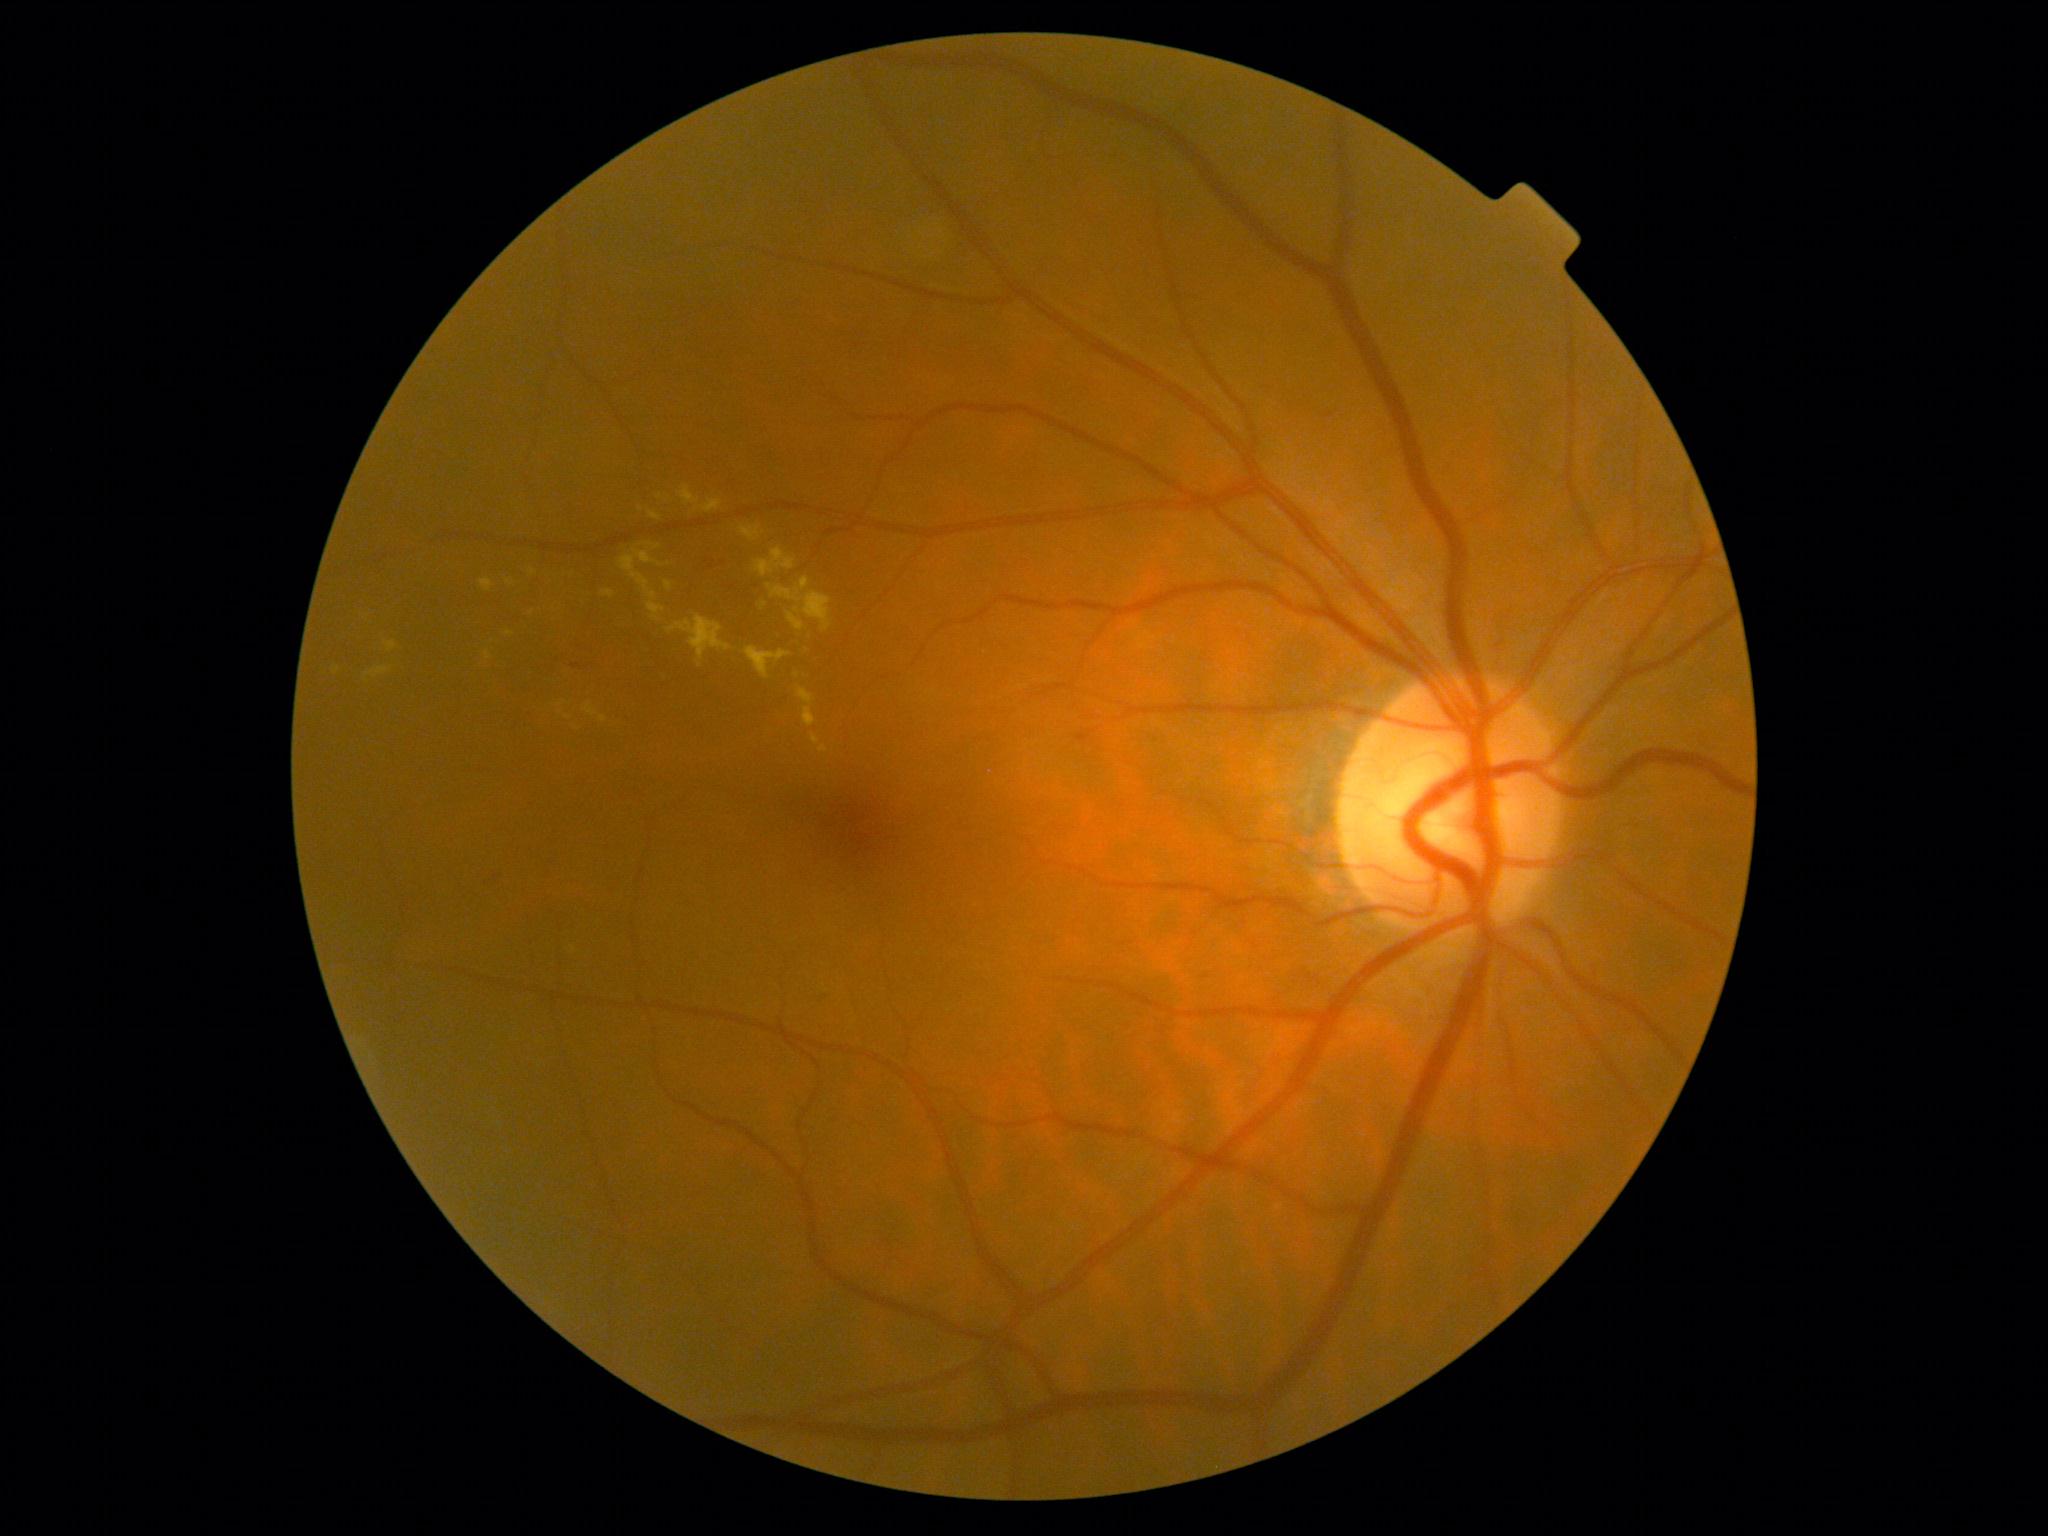 DR severity: grade 2.